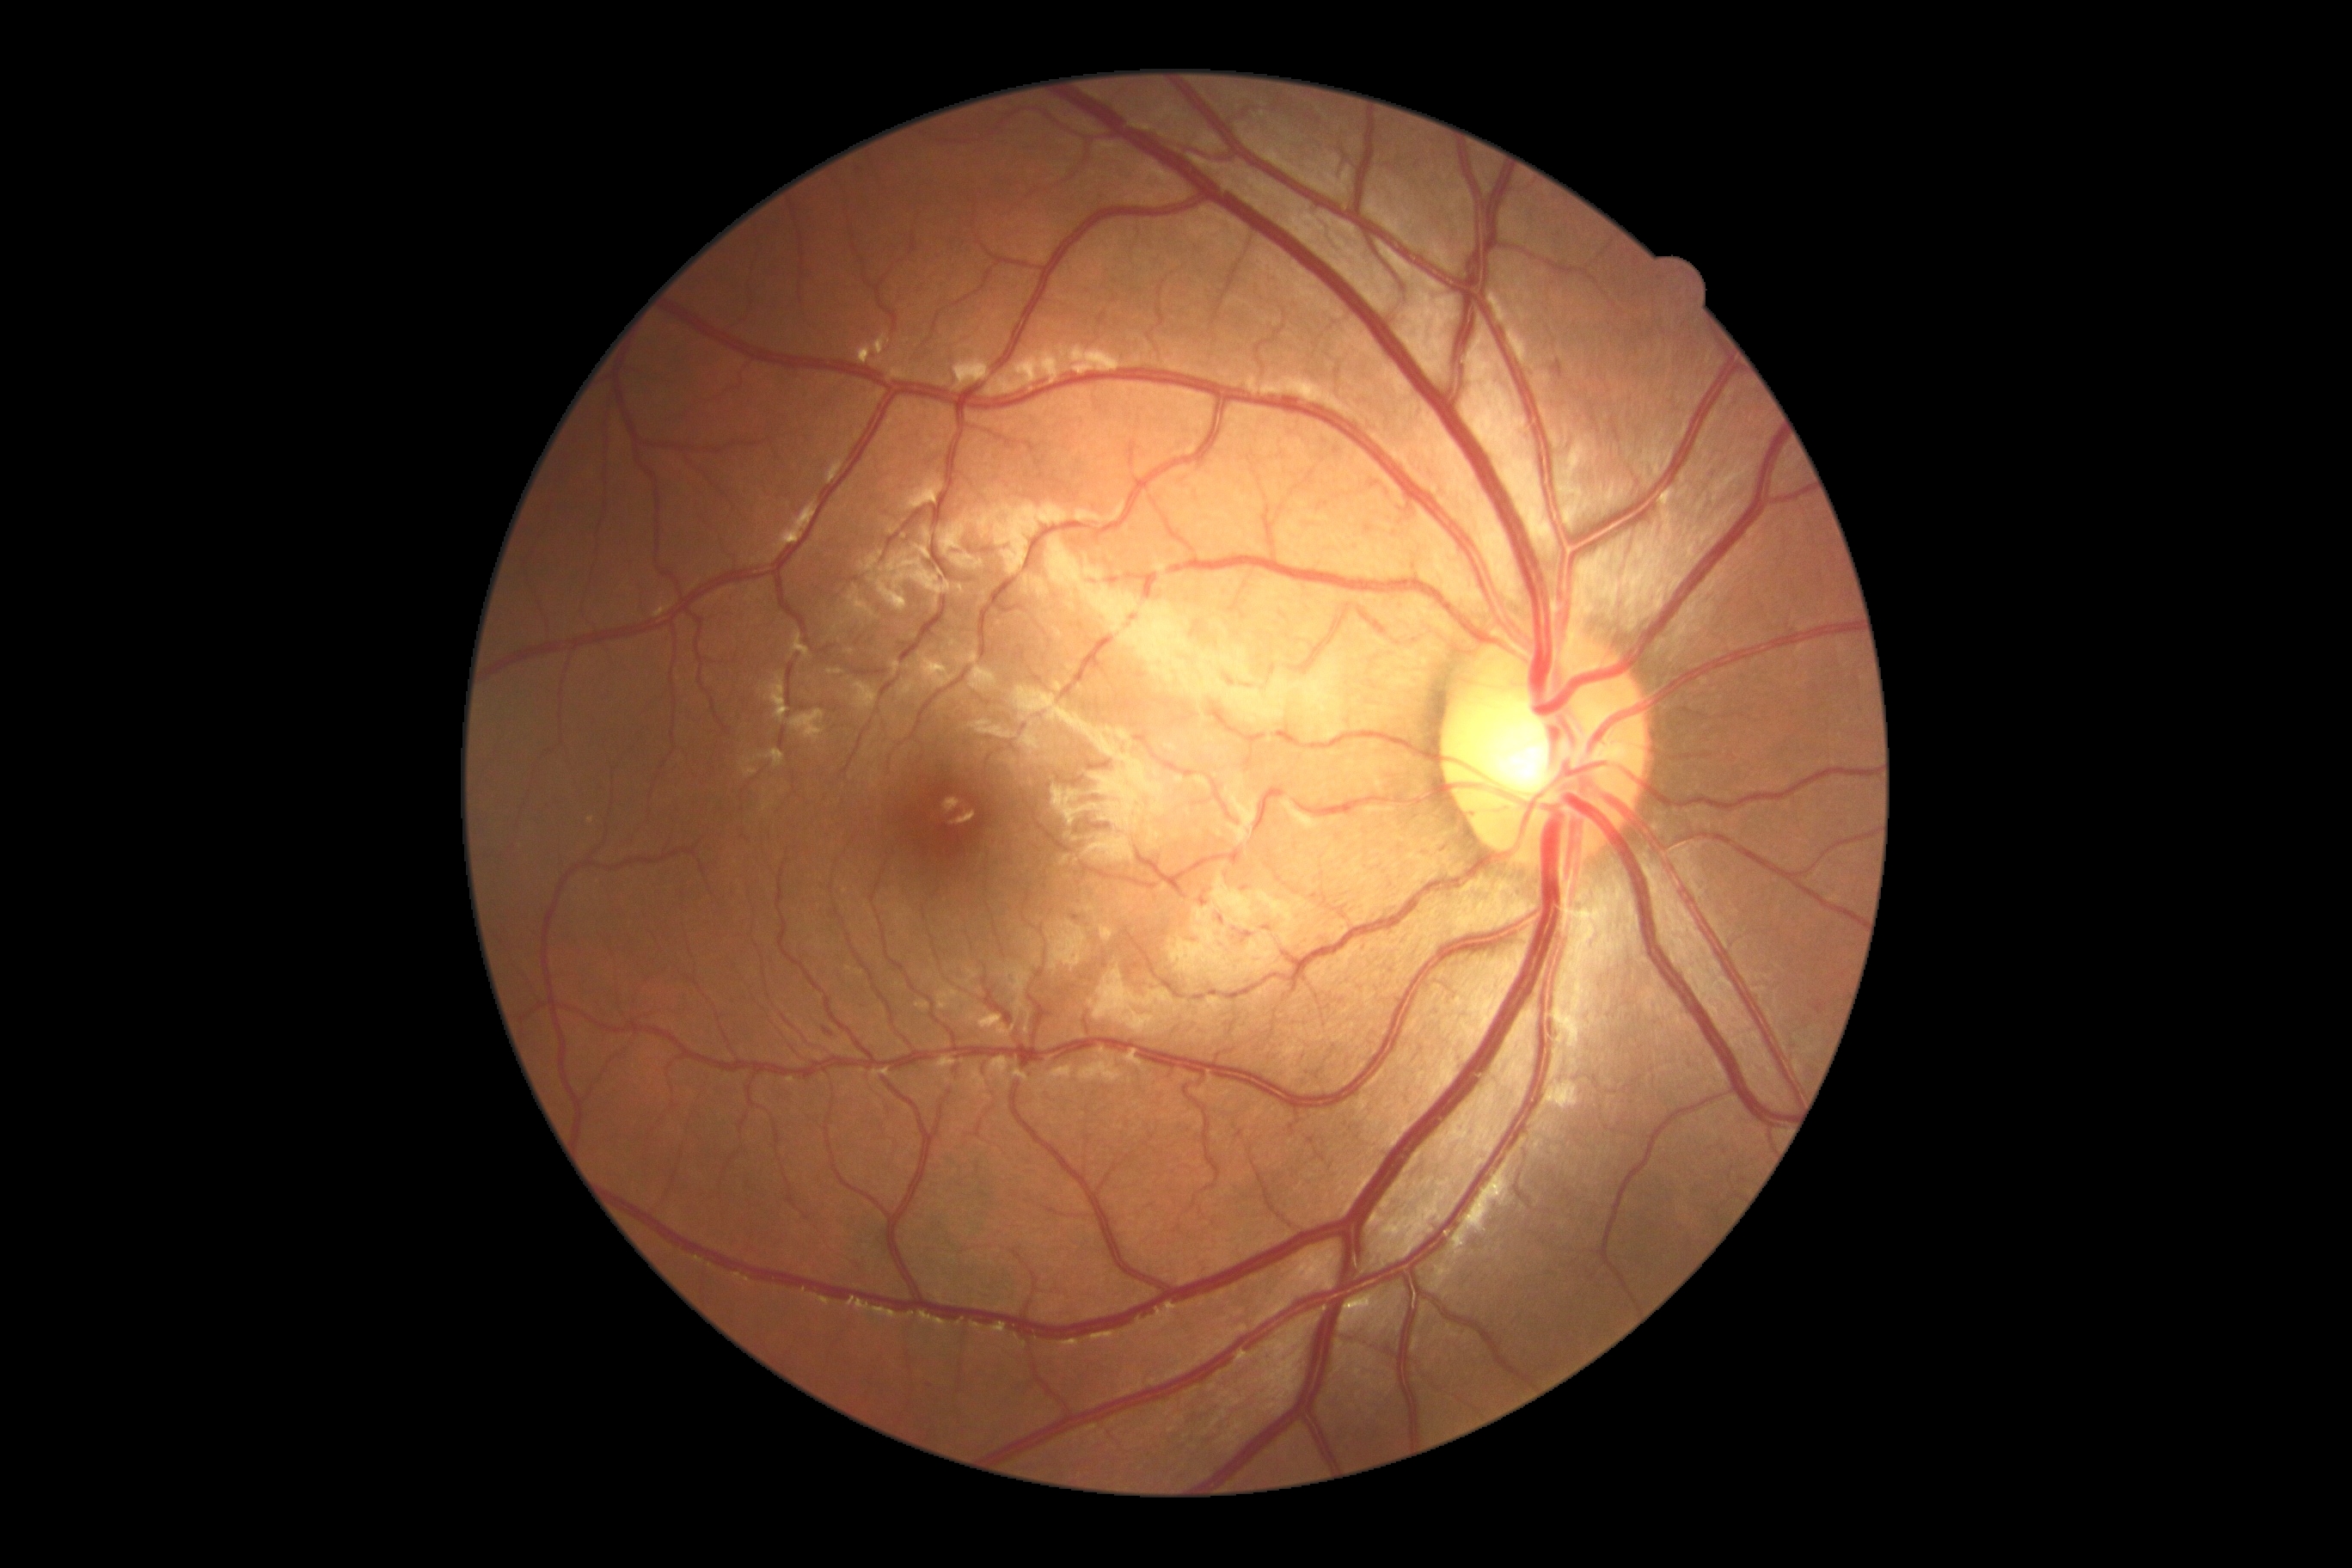
diabetic retinopathy severity = grade 2 (moderate NPDR).